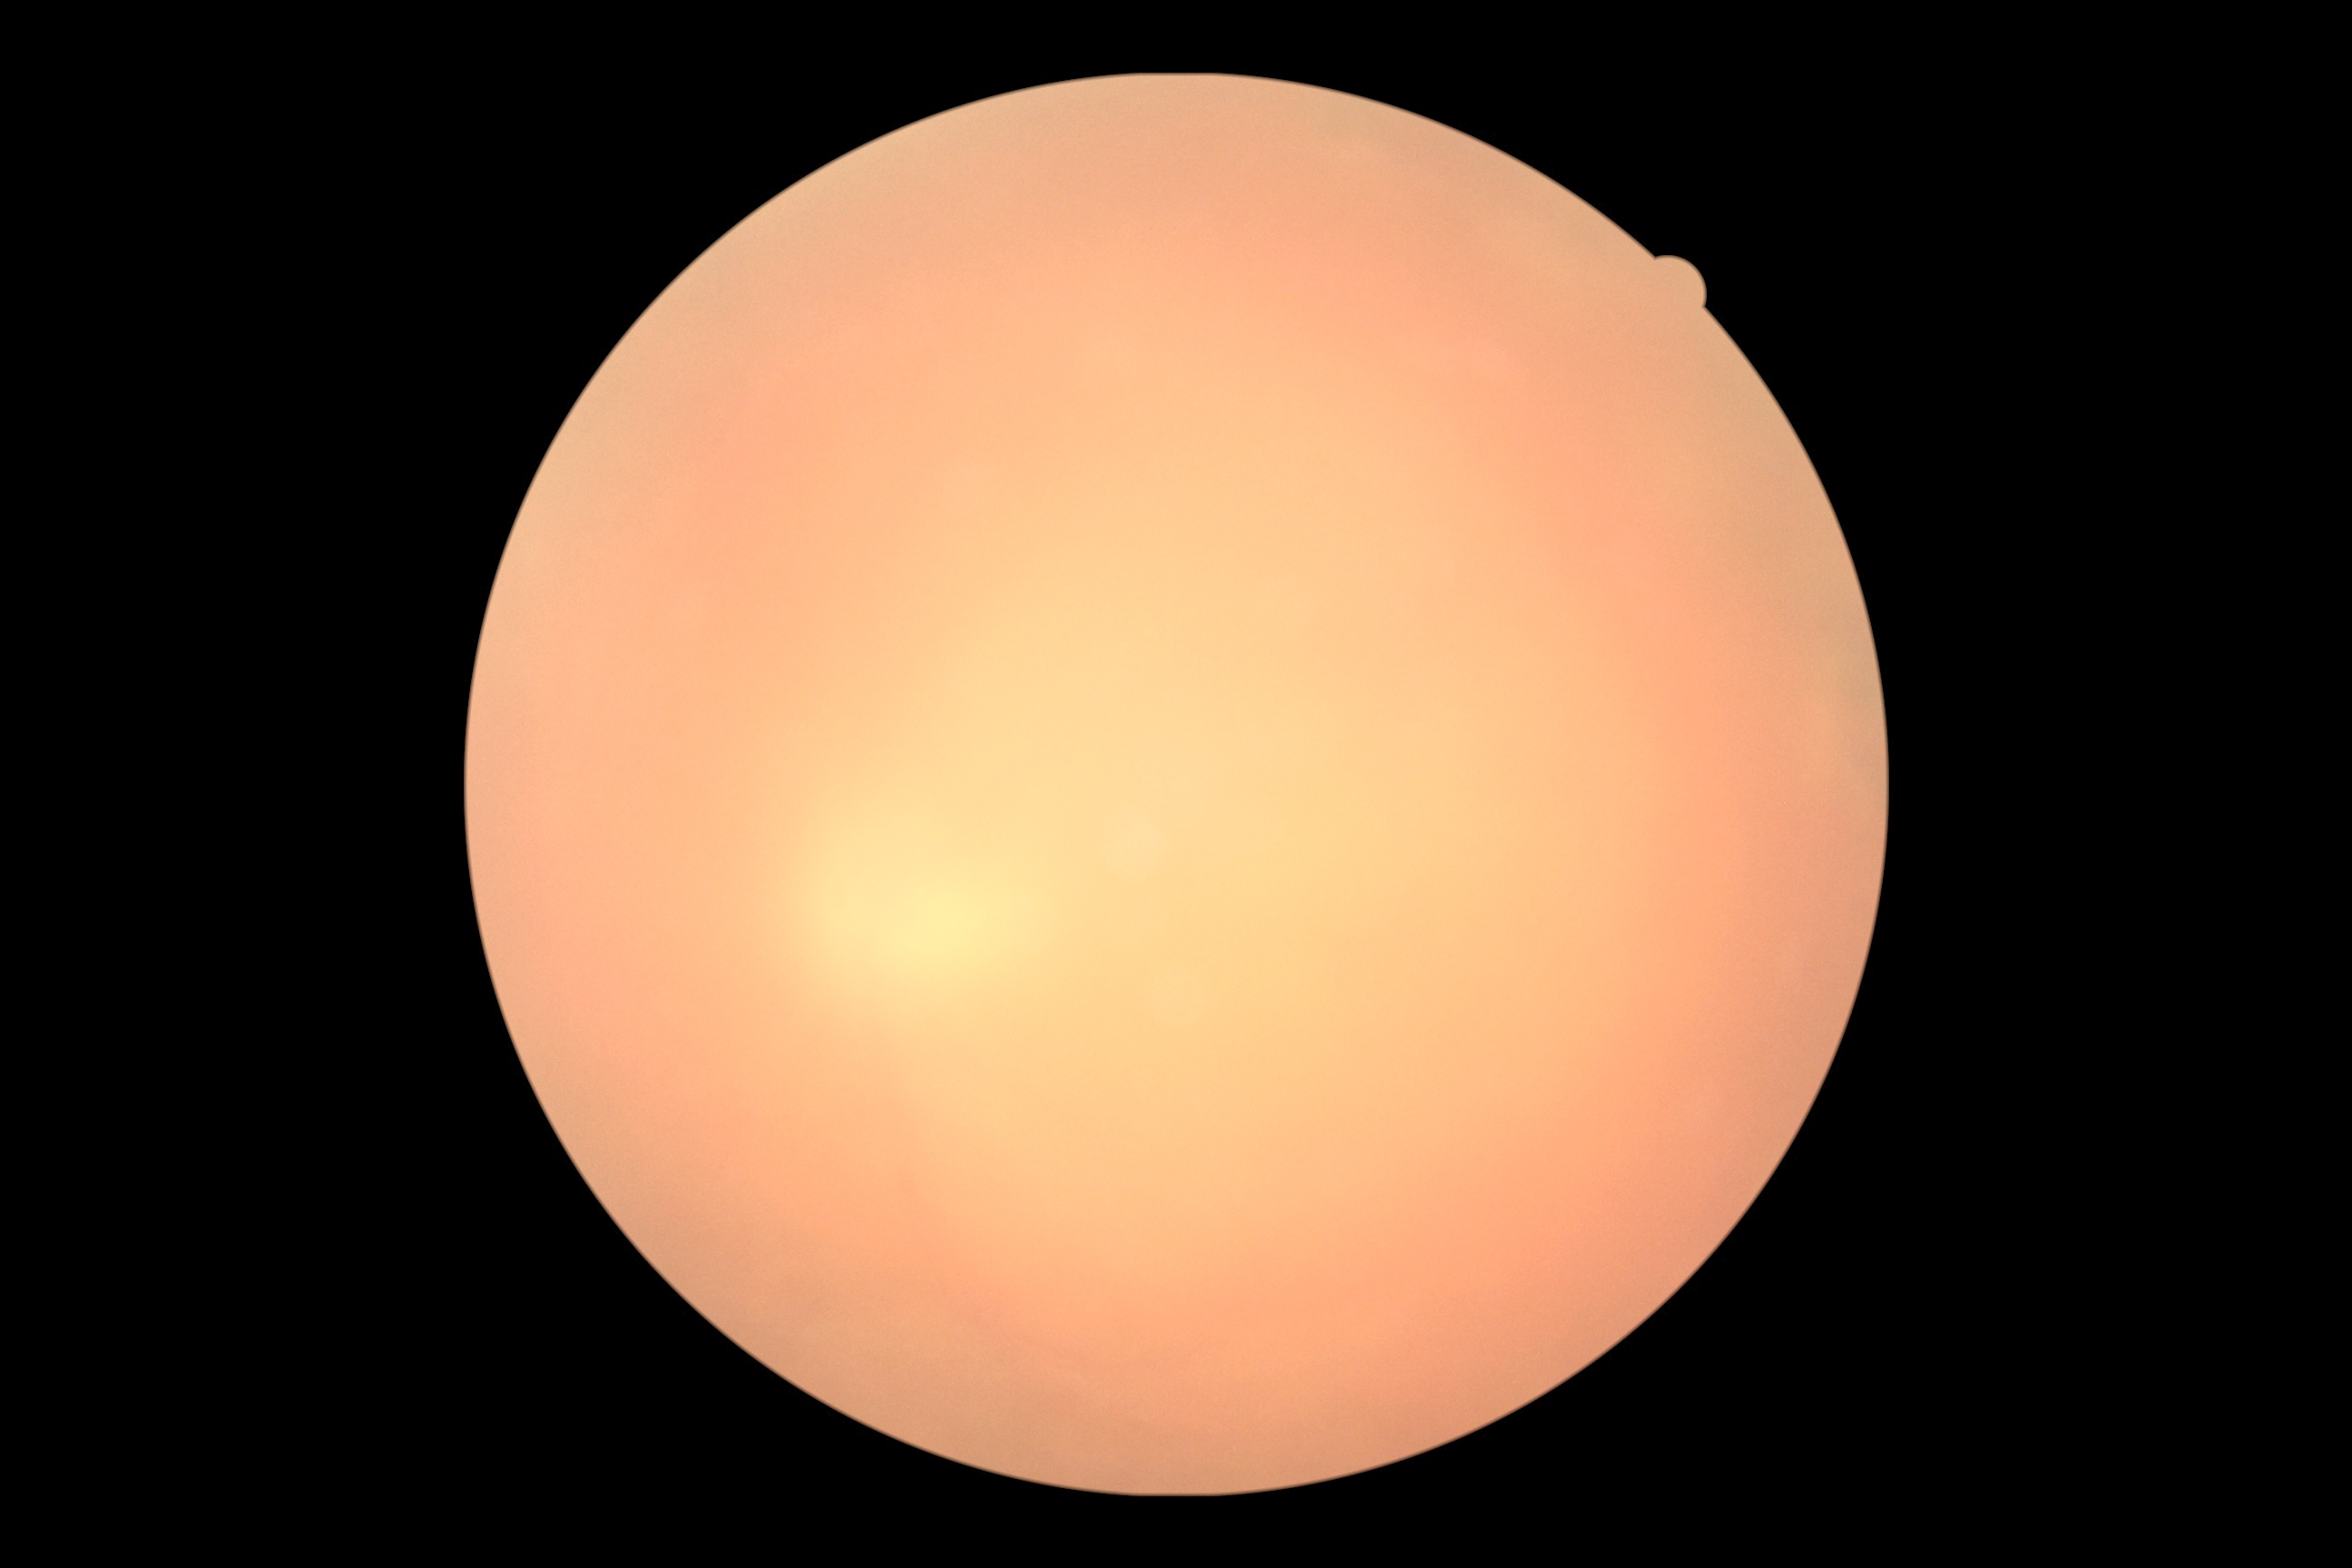 {
  "dr_grade": "ungradable",
  "quality": "insufficient for DR assessment"
}